Optic disc-centered crop from a color fundus photograph
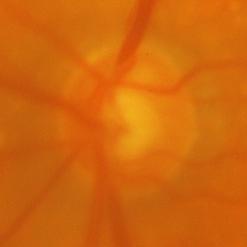 Glaucomatous changes are present. Glaucoma diagnosis: present.